CFP
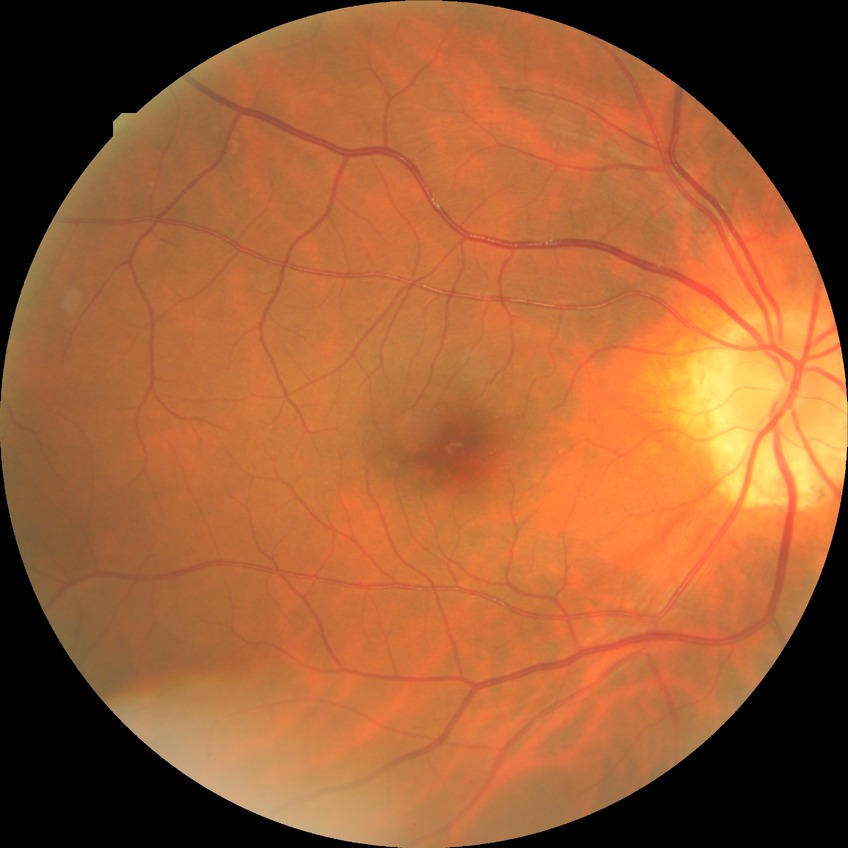
diabetic retinopathy (DR): NDR (no diabetic retinopathy).